Wide-field fundus photograph of an infant. Camera: Clarity RetCam 3 (130° FOV).
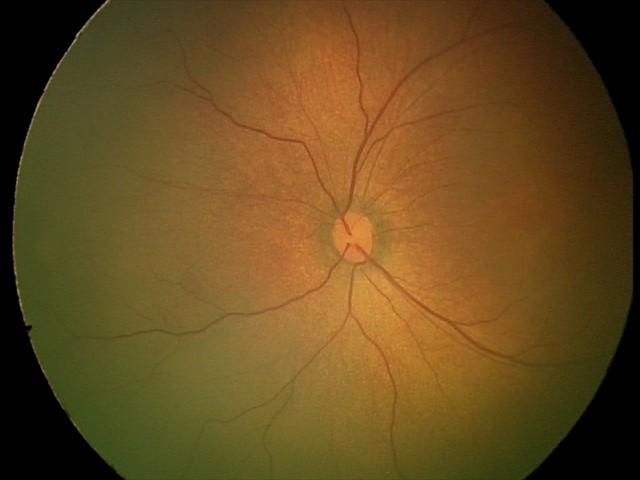 Q: What was the screening finding?
A: physiological retinal finding